Image size 640x480. Wide-field fundus photograph of an infant — 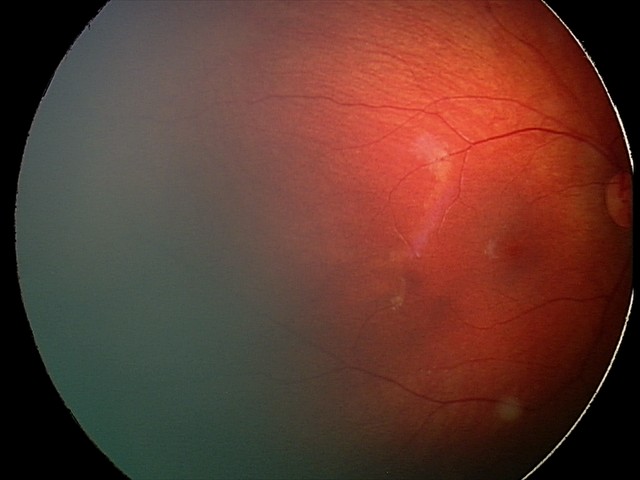
Screening series with retinal hemorrhages.